Color fundus image — 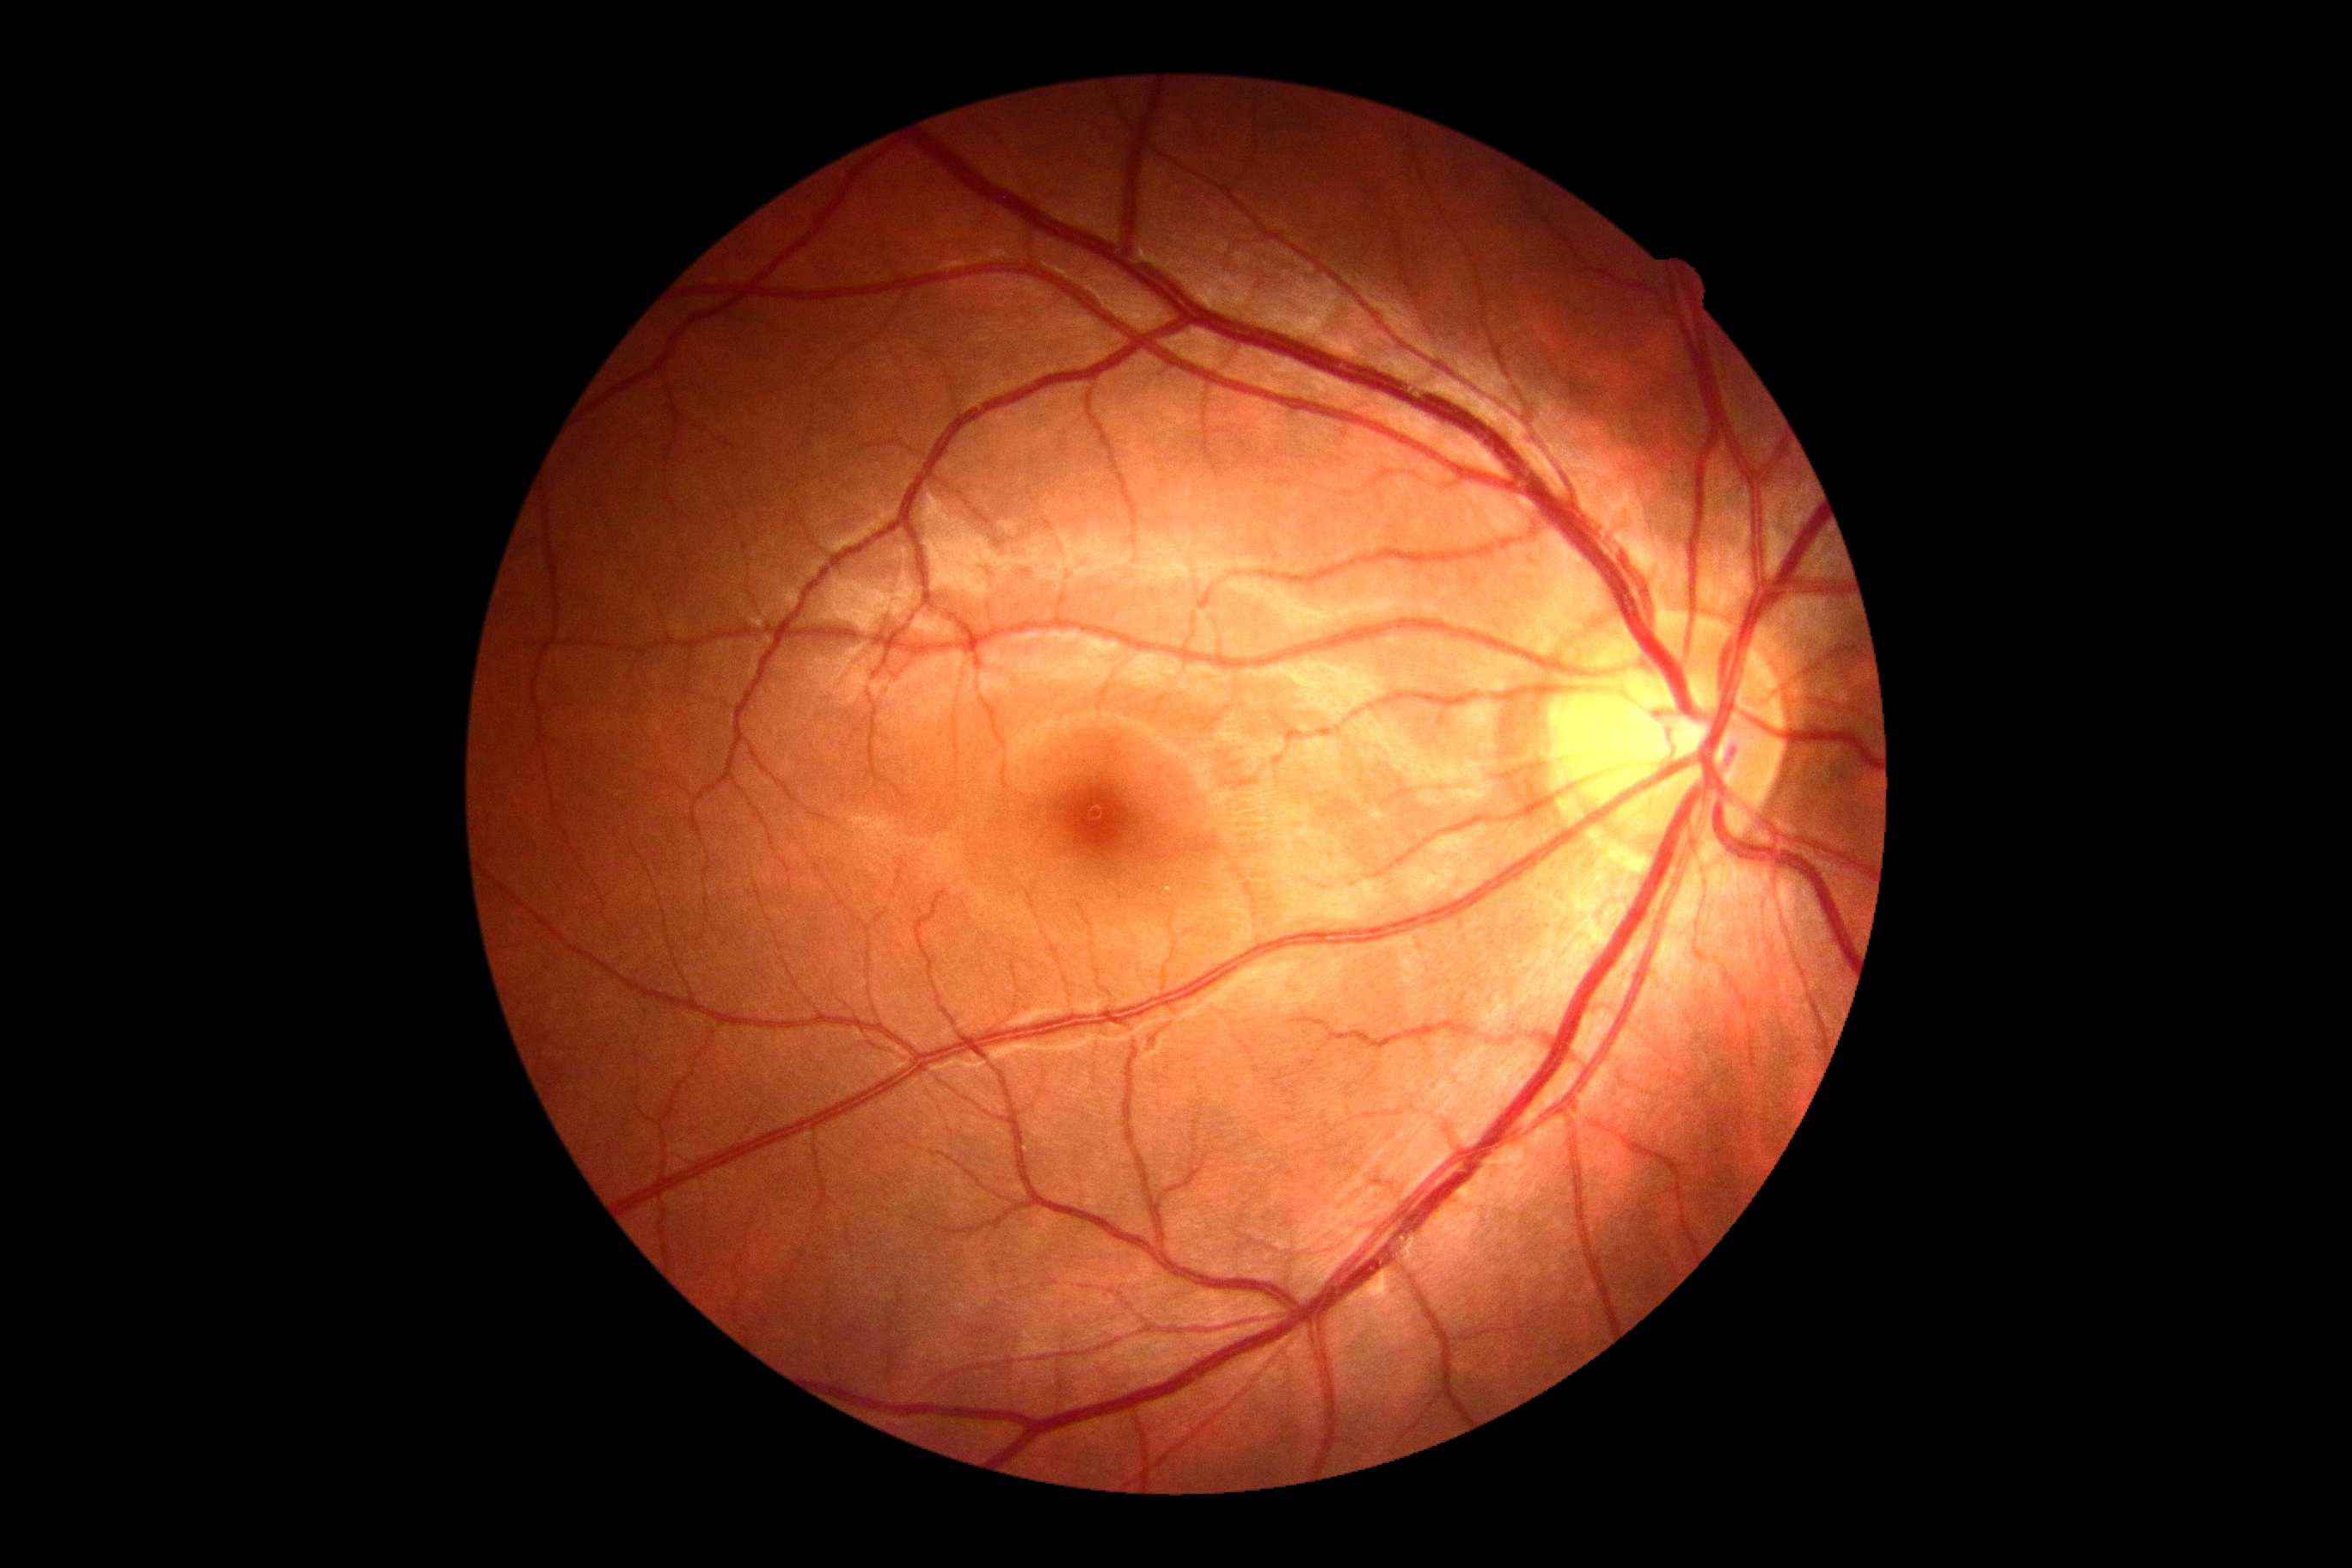

DR stage: 0.